Wide-field contact fundus photograph of an infant. 640 by 480 pixels
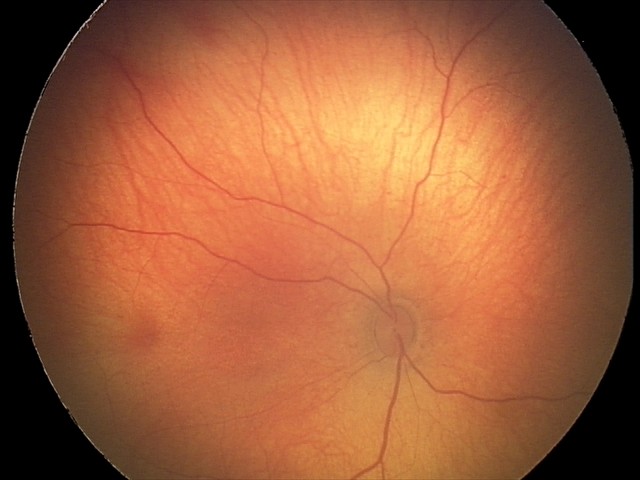 Series diagnosed as retinal hemorrhages.